Color fundus photograph
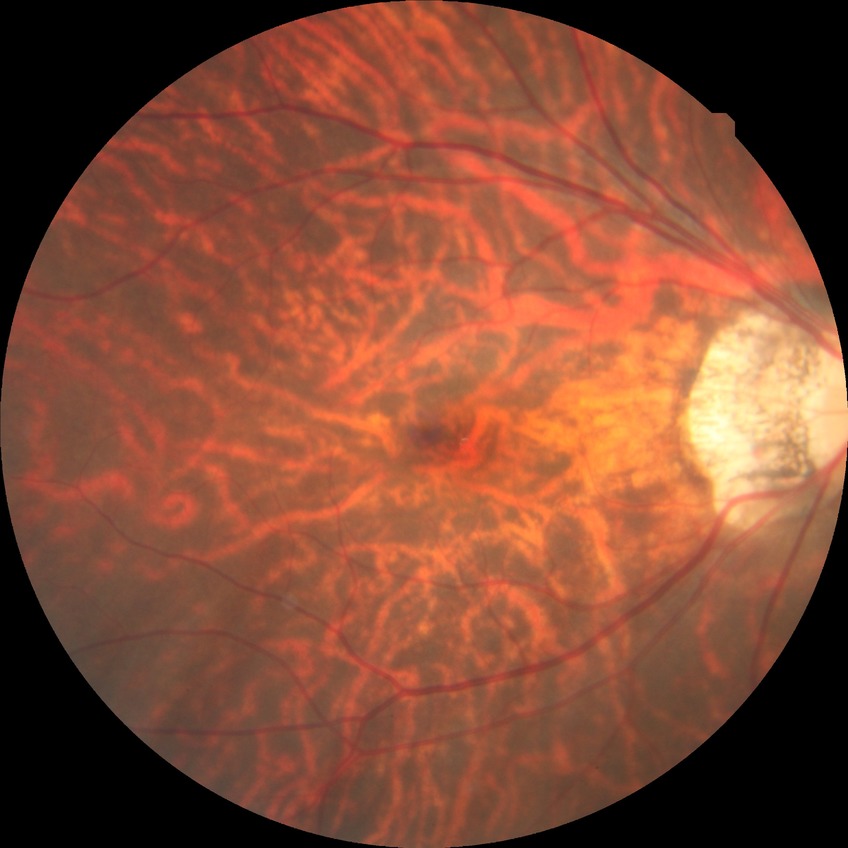

Davis grade: NDR.